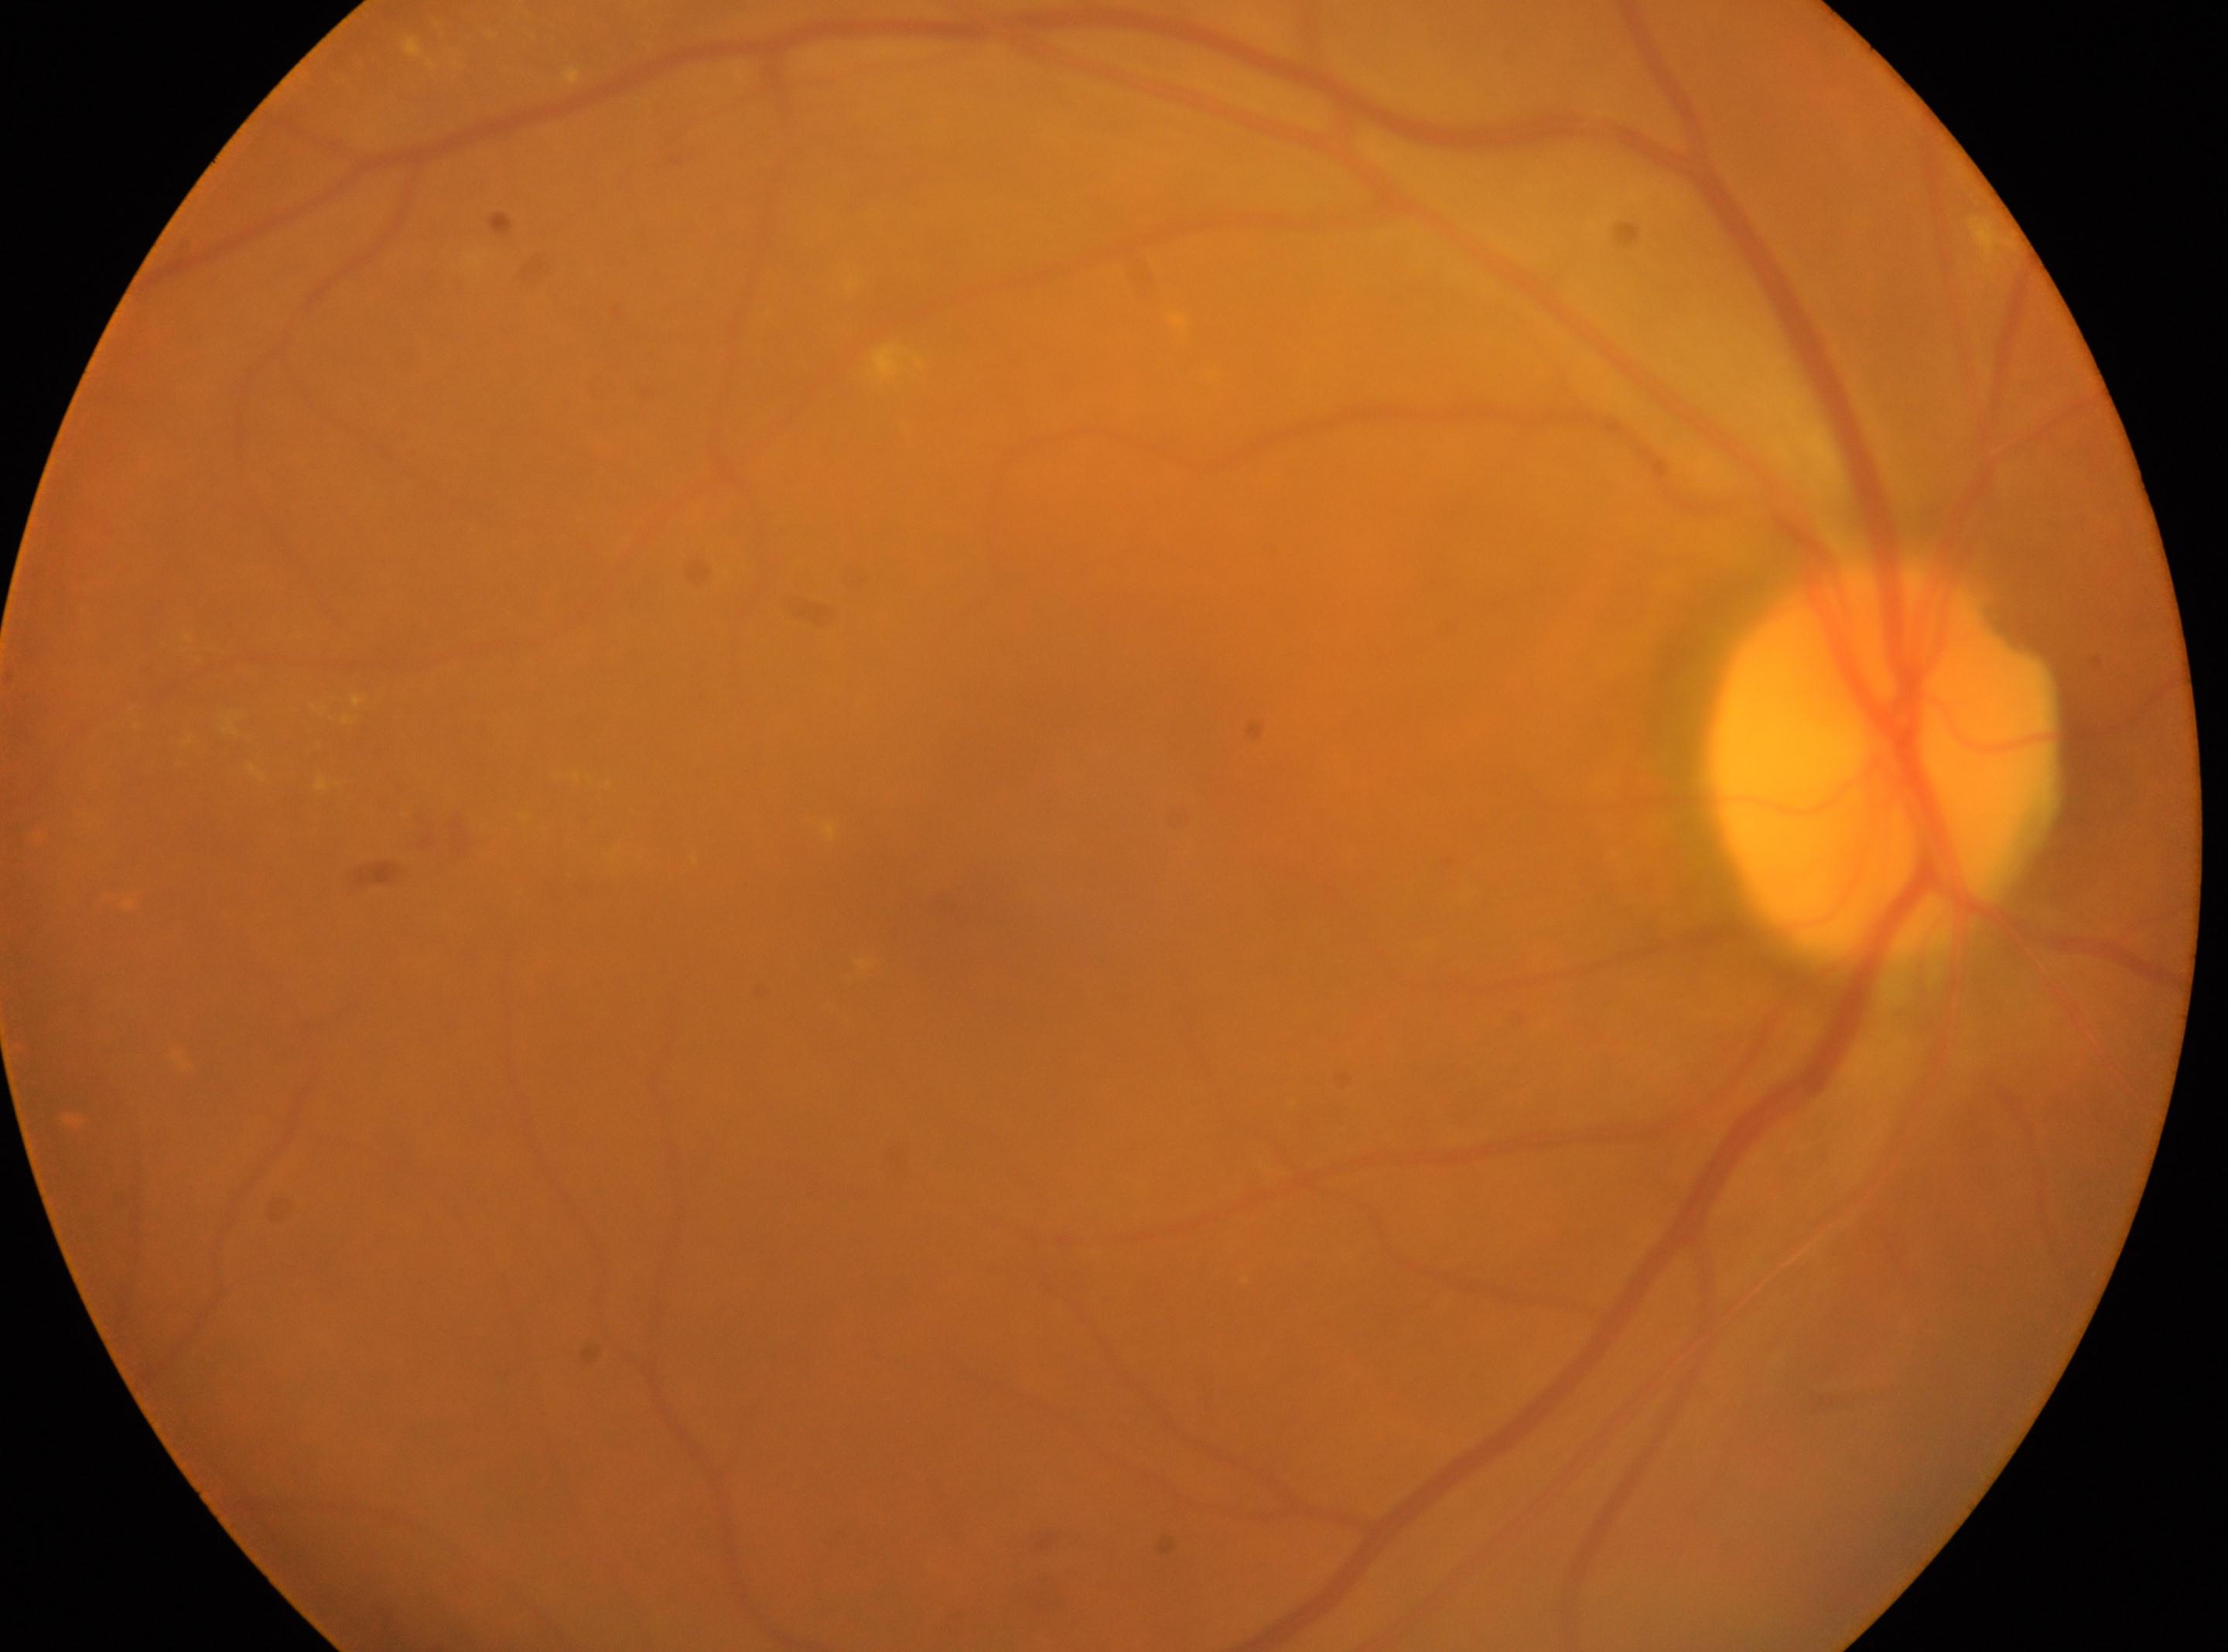
Imaged eye: right. Optic disk: x=1881, y=766. The macula center is at x=944, y=896. The retinopathy is classified as non-proliferative diabetic retinopathy. DR severity is grade 2.